CFP; 2352x1568px: 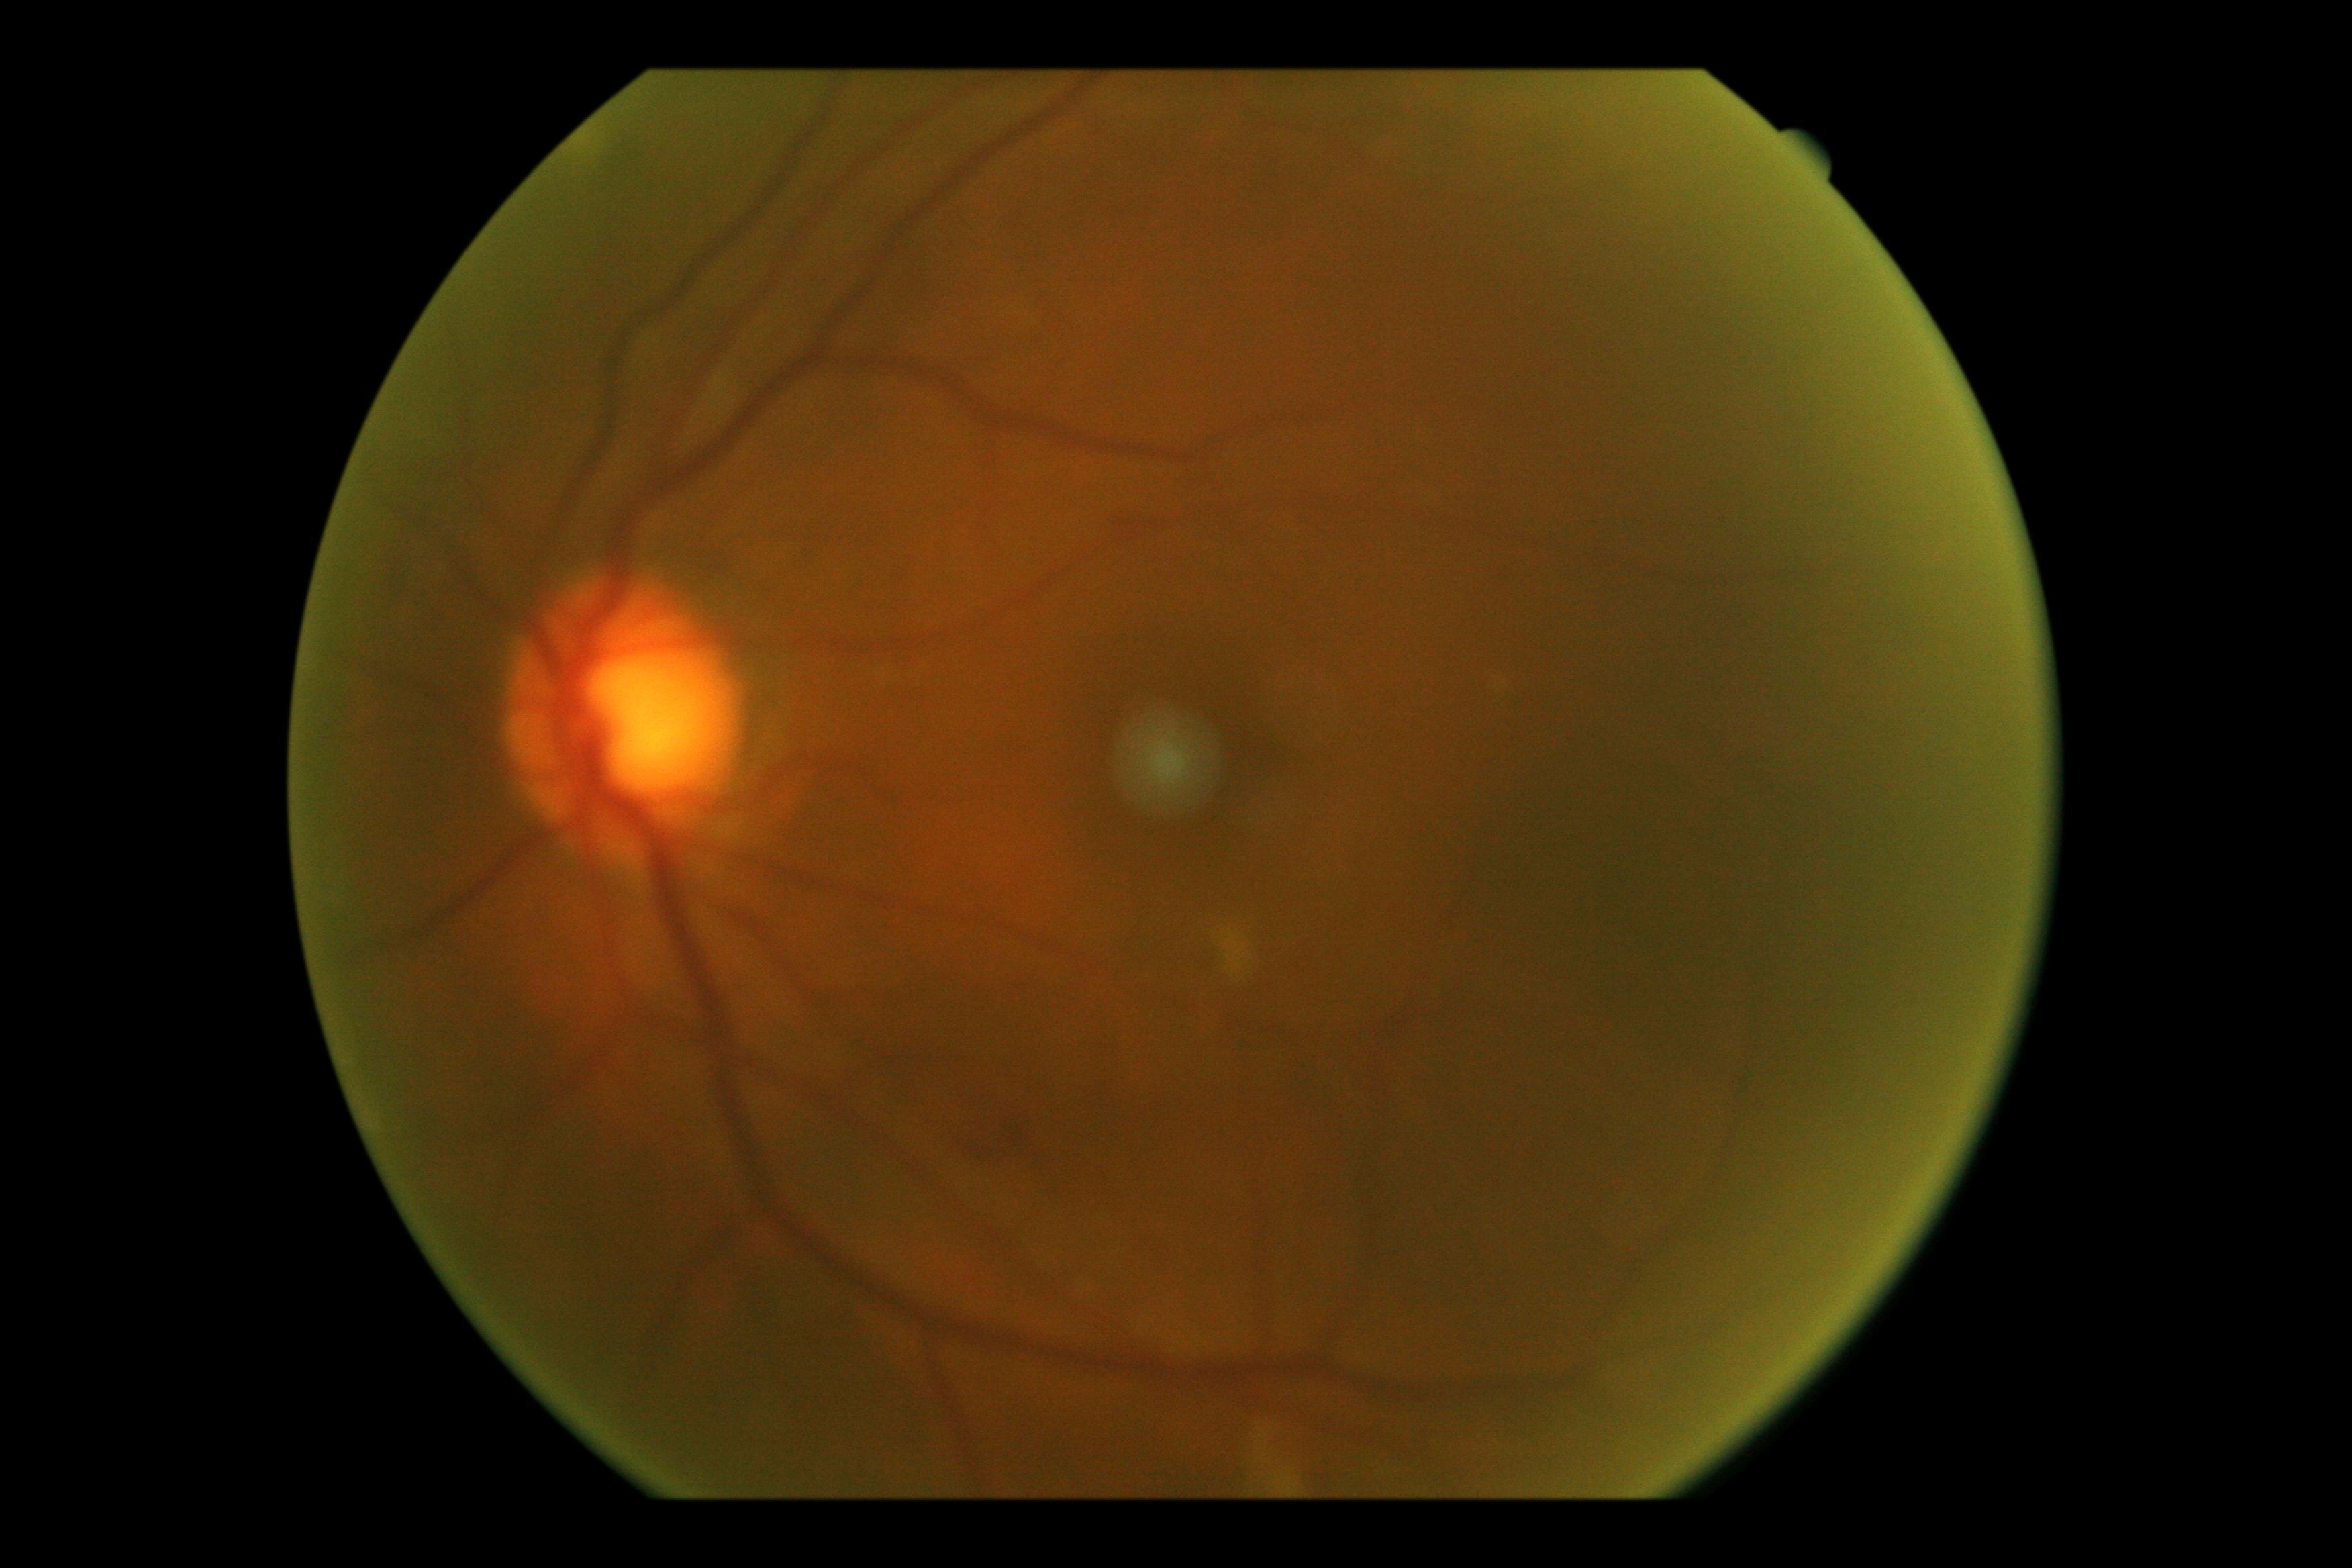
The retinopathy is classified as non-proliferative diabetic retinopathy.
DR: 2.